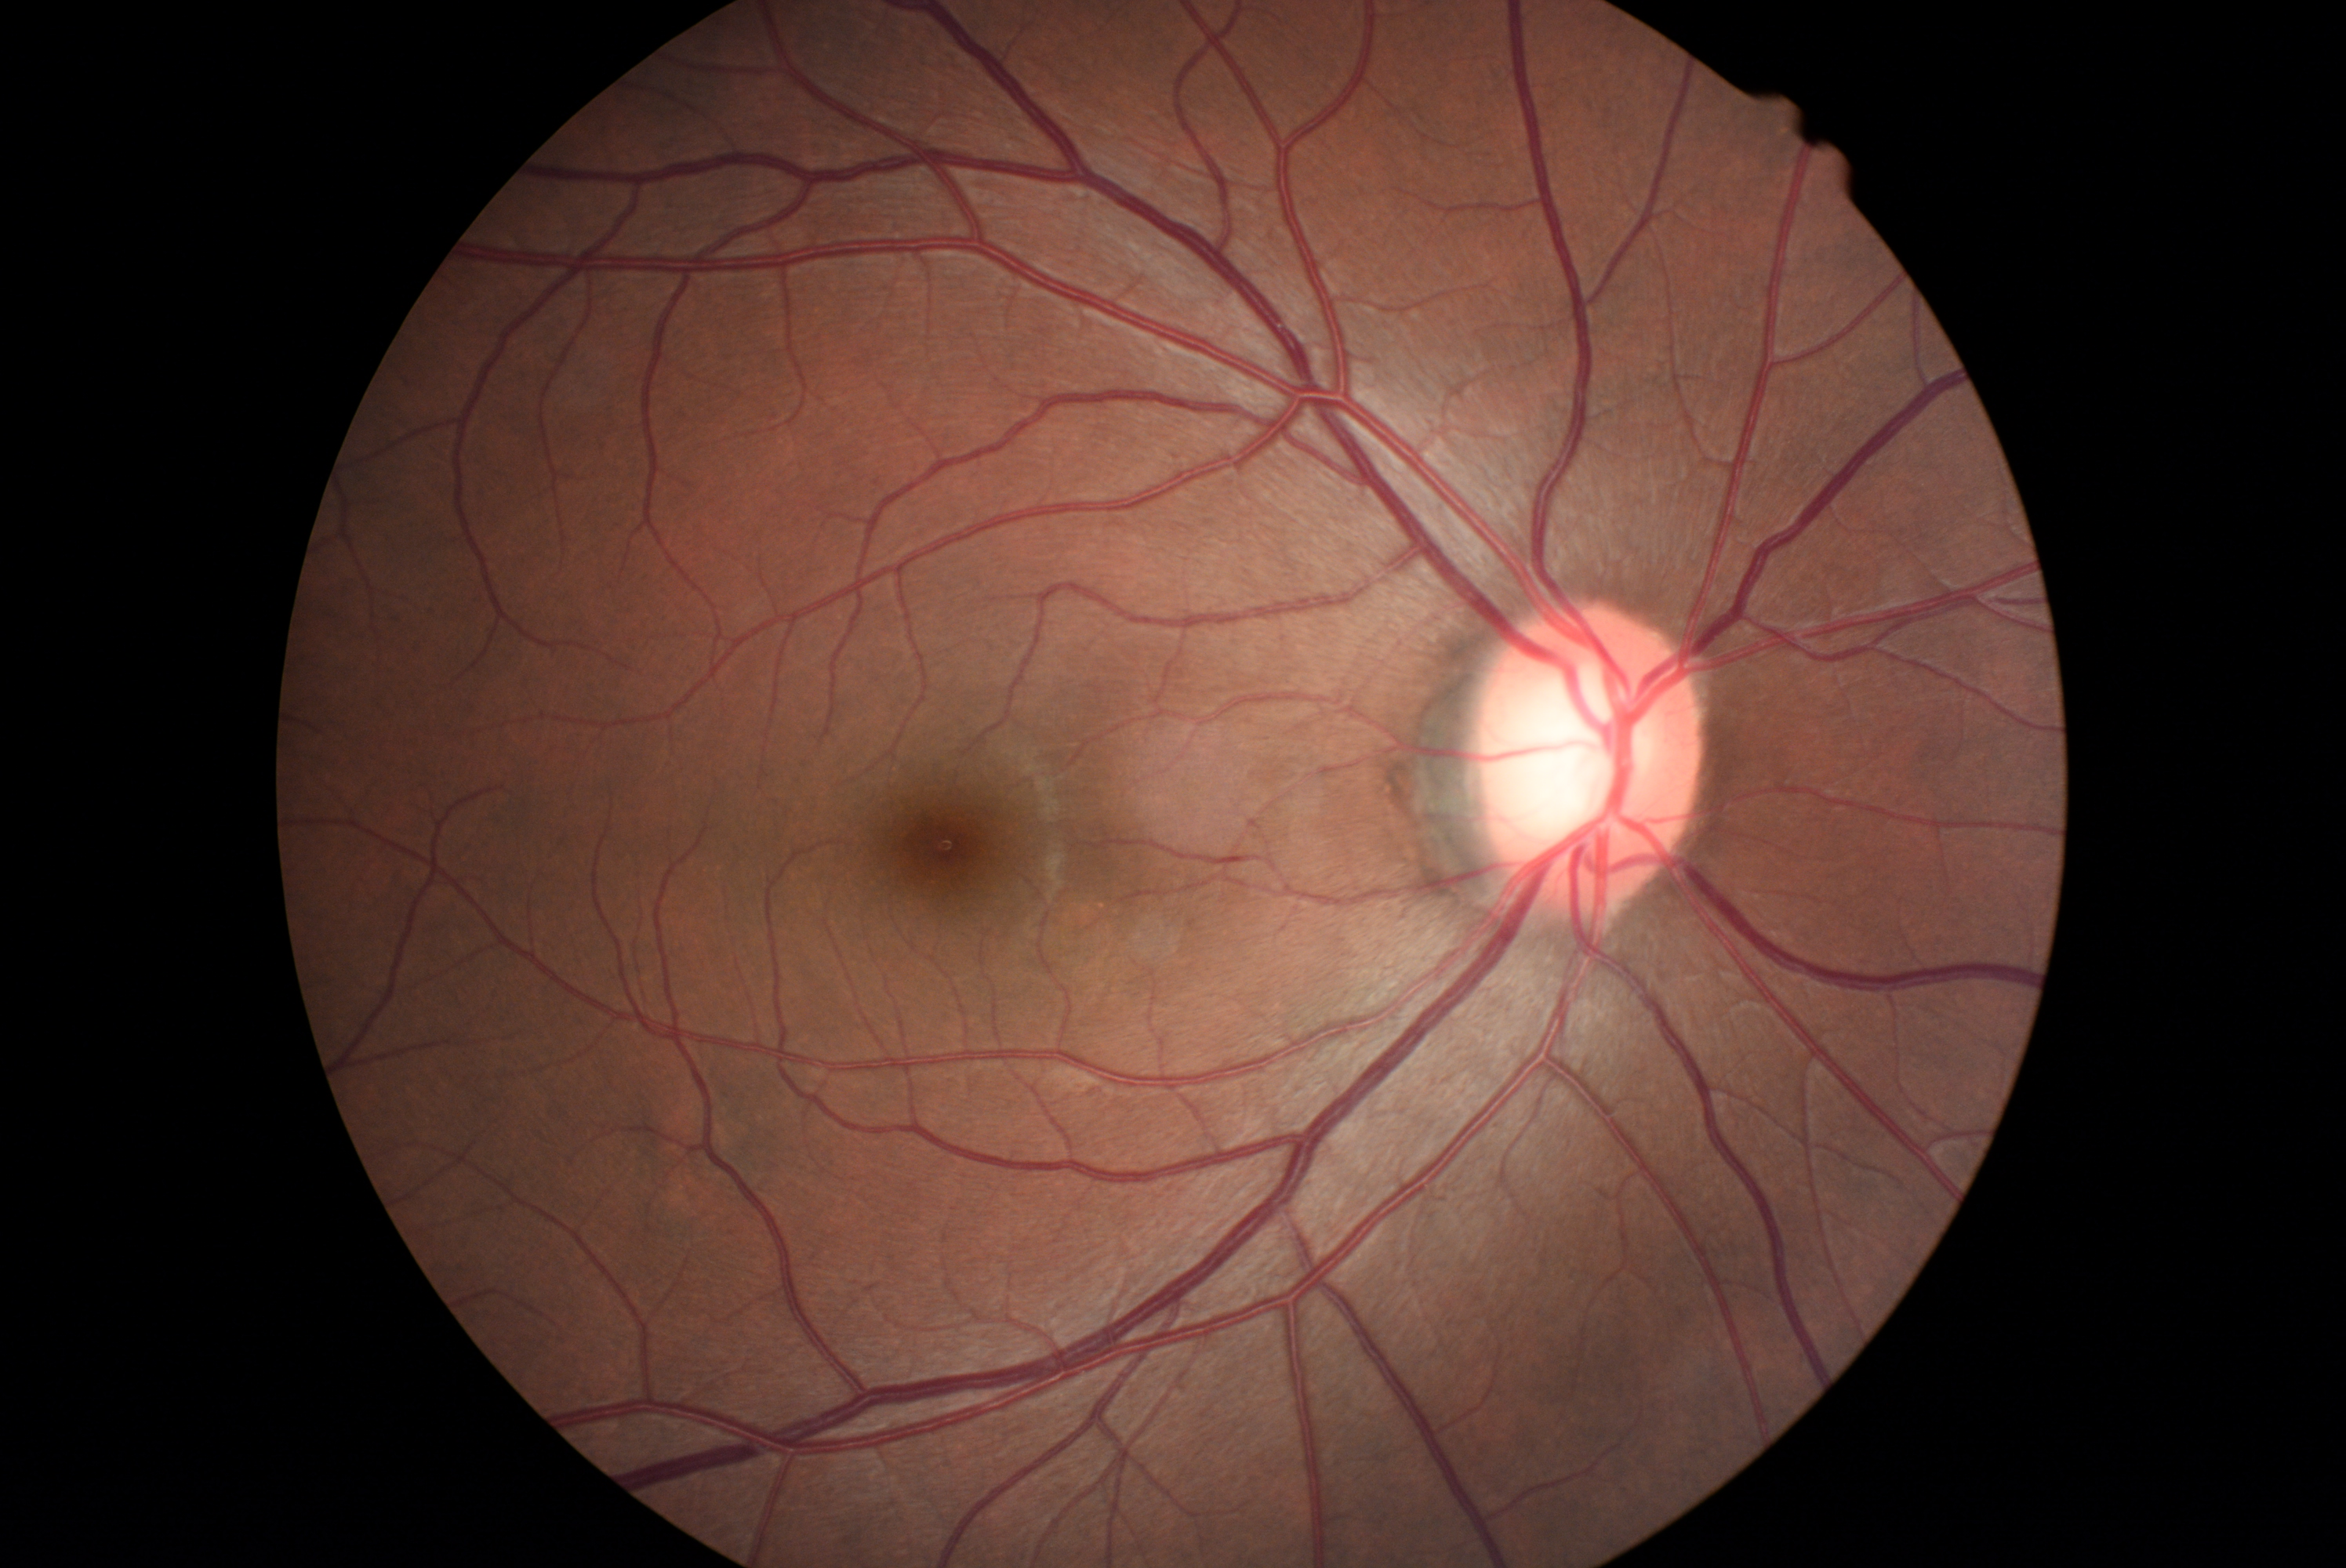

{
  "dr_grade": "grade 0 (no apparent retinopathy) — no visible signs of diabetic retinopathy",
  "dr_impression": "negative for DR"
}